Macula at the center of the field — 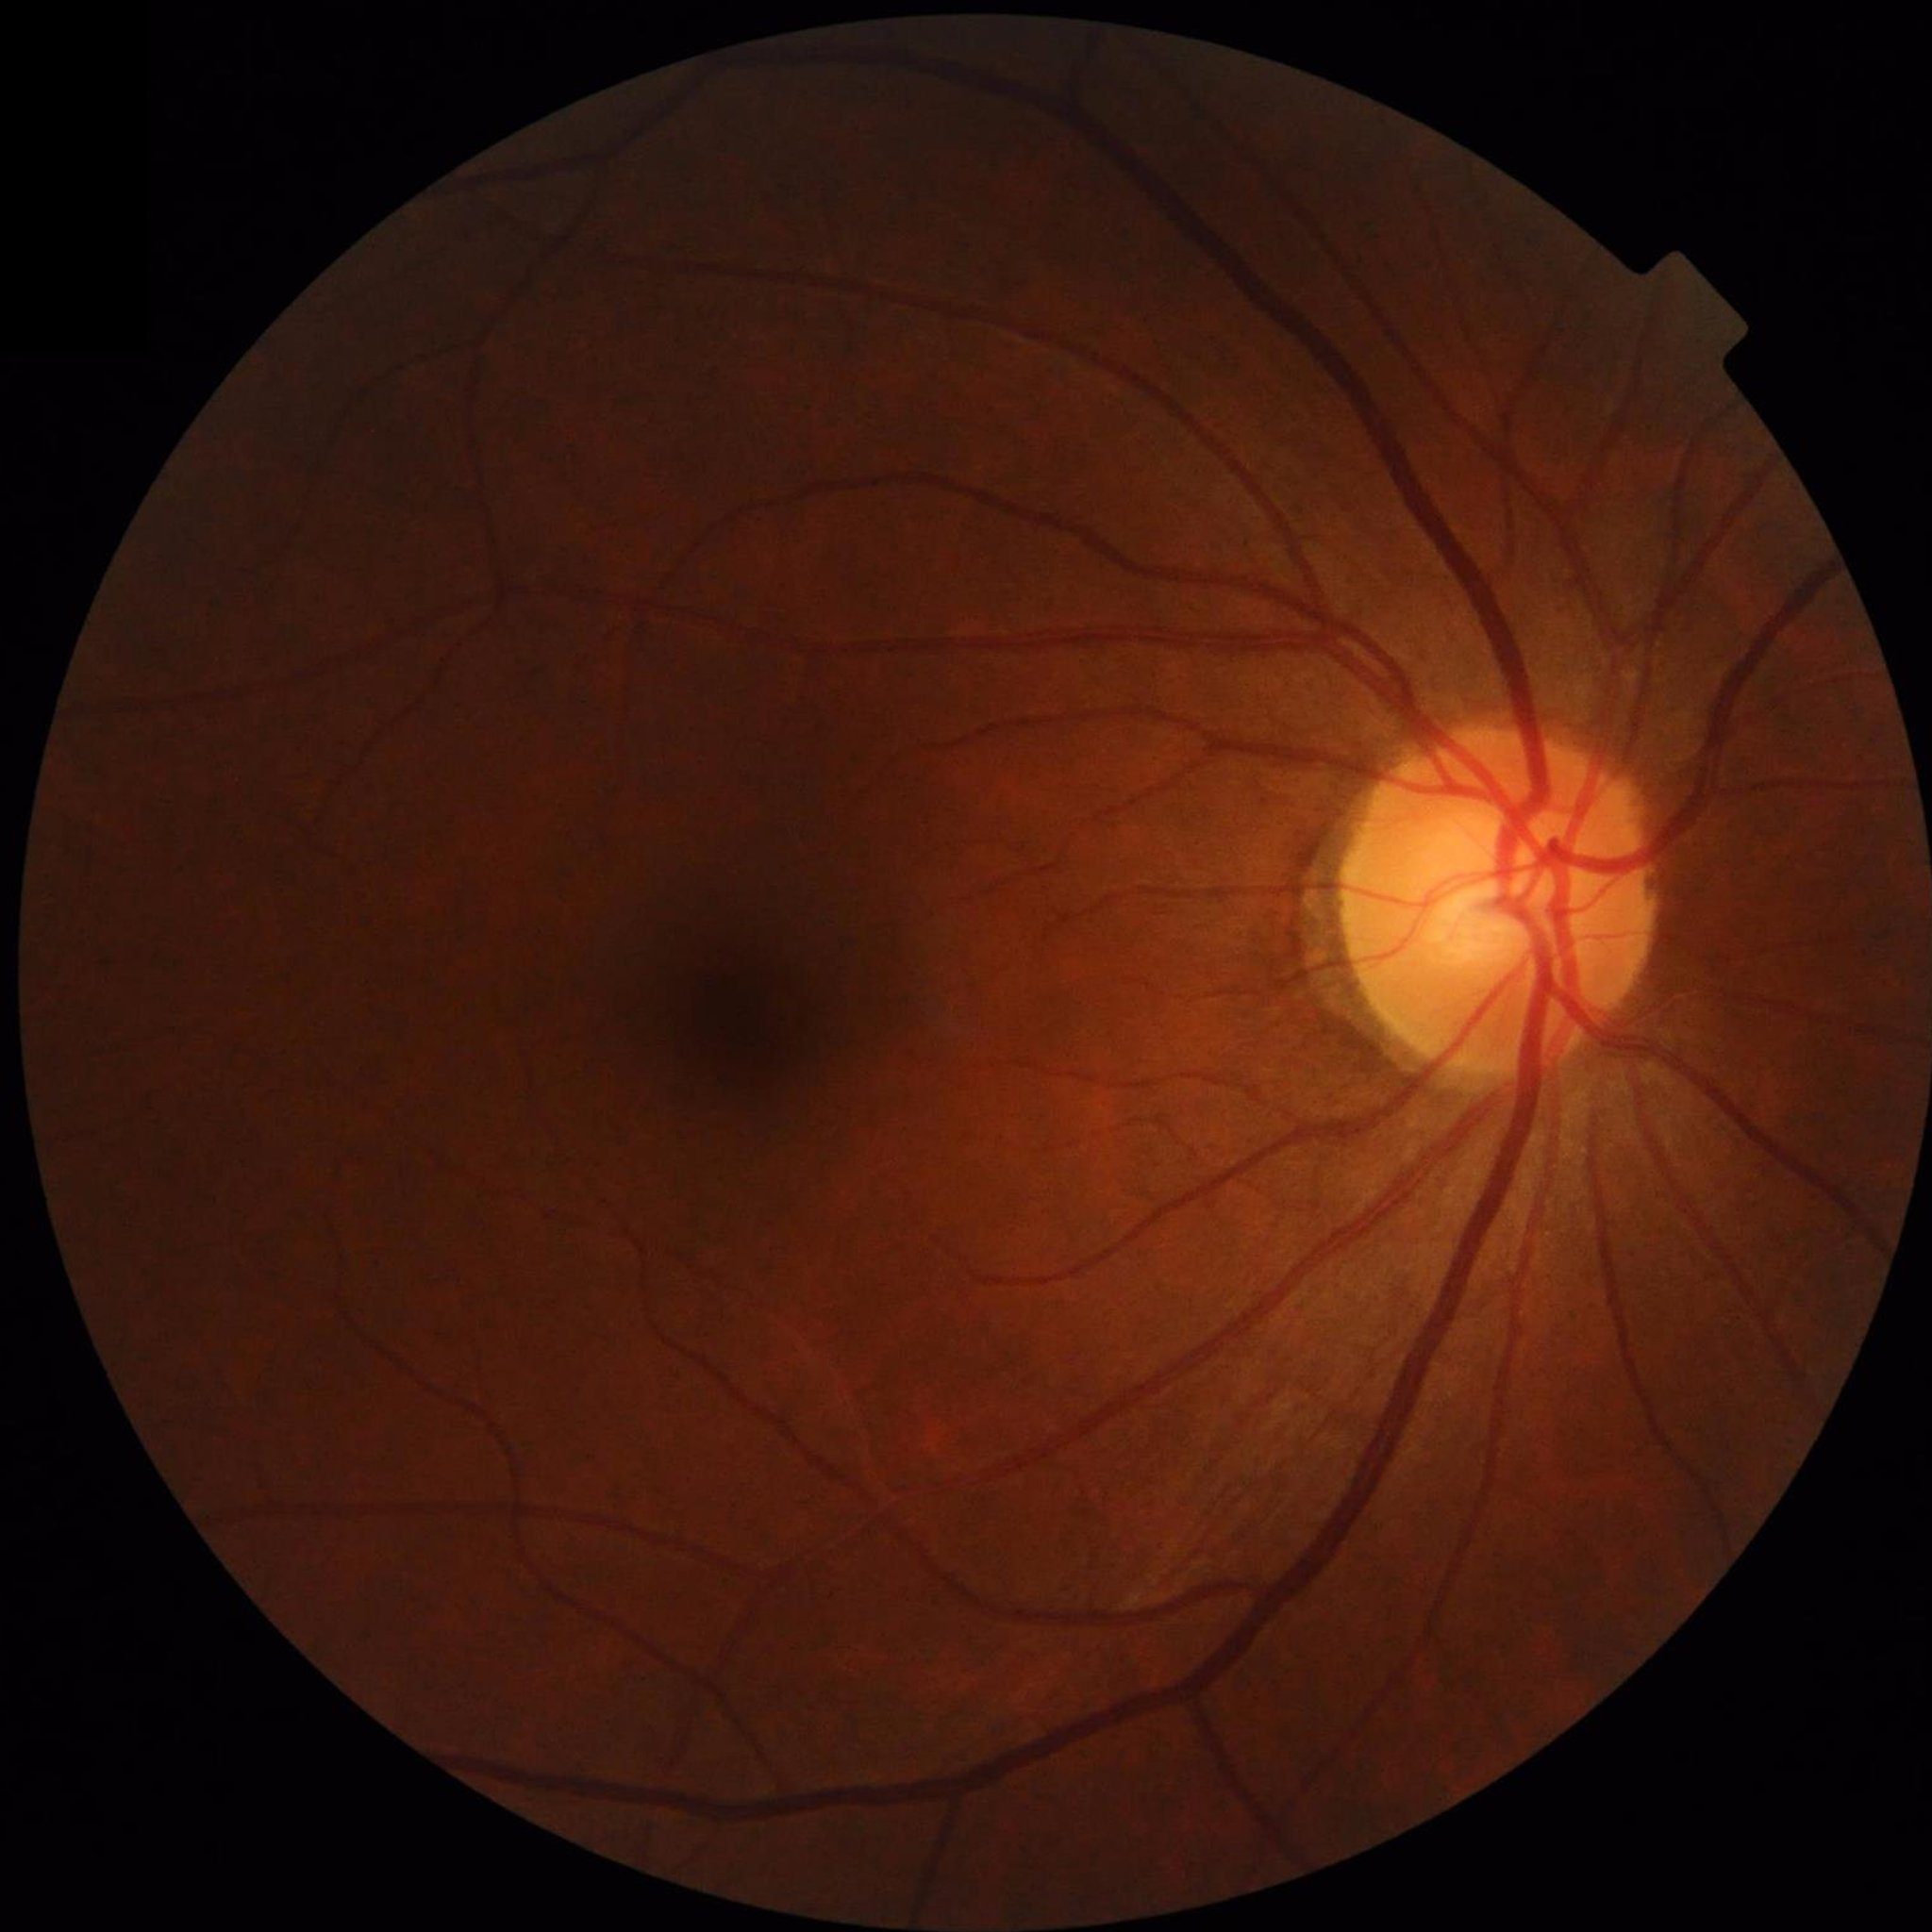 Retinal fundus photograph from a control without AMD, DR, or glaucoma. Automated quality assessment: adequate.